Nonmydriatic. 45° FOV:
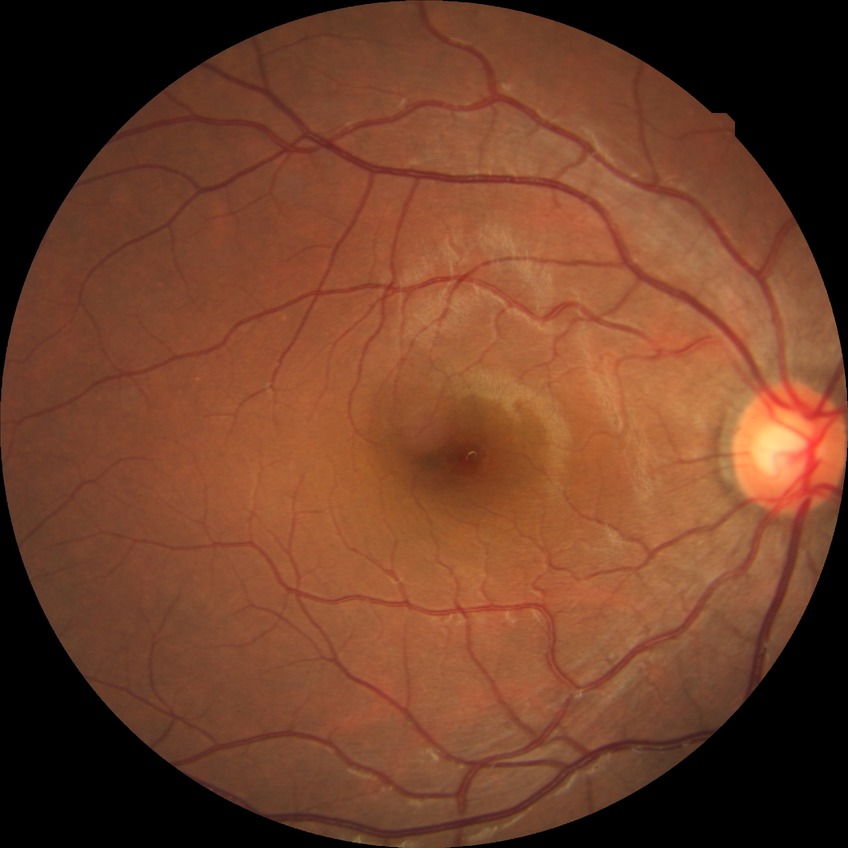
DR@NDR; DR impression@no signs of DR.